Image size 2352x1568, fundus photo — 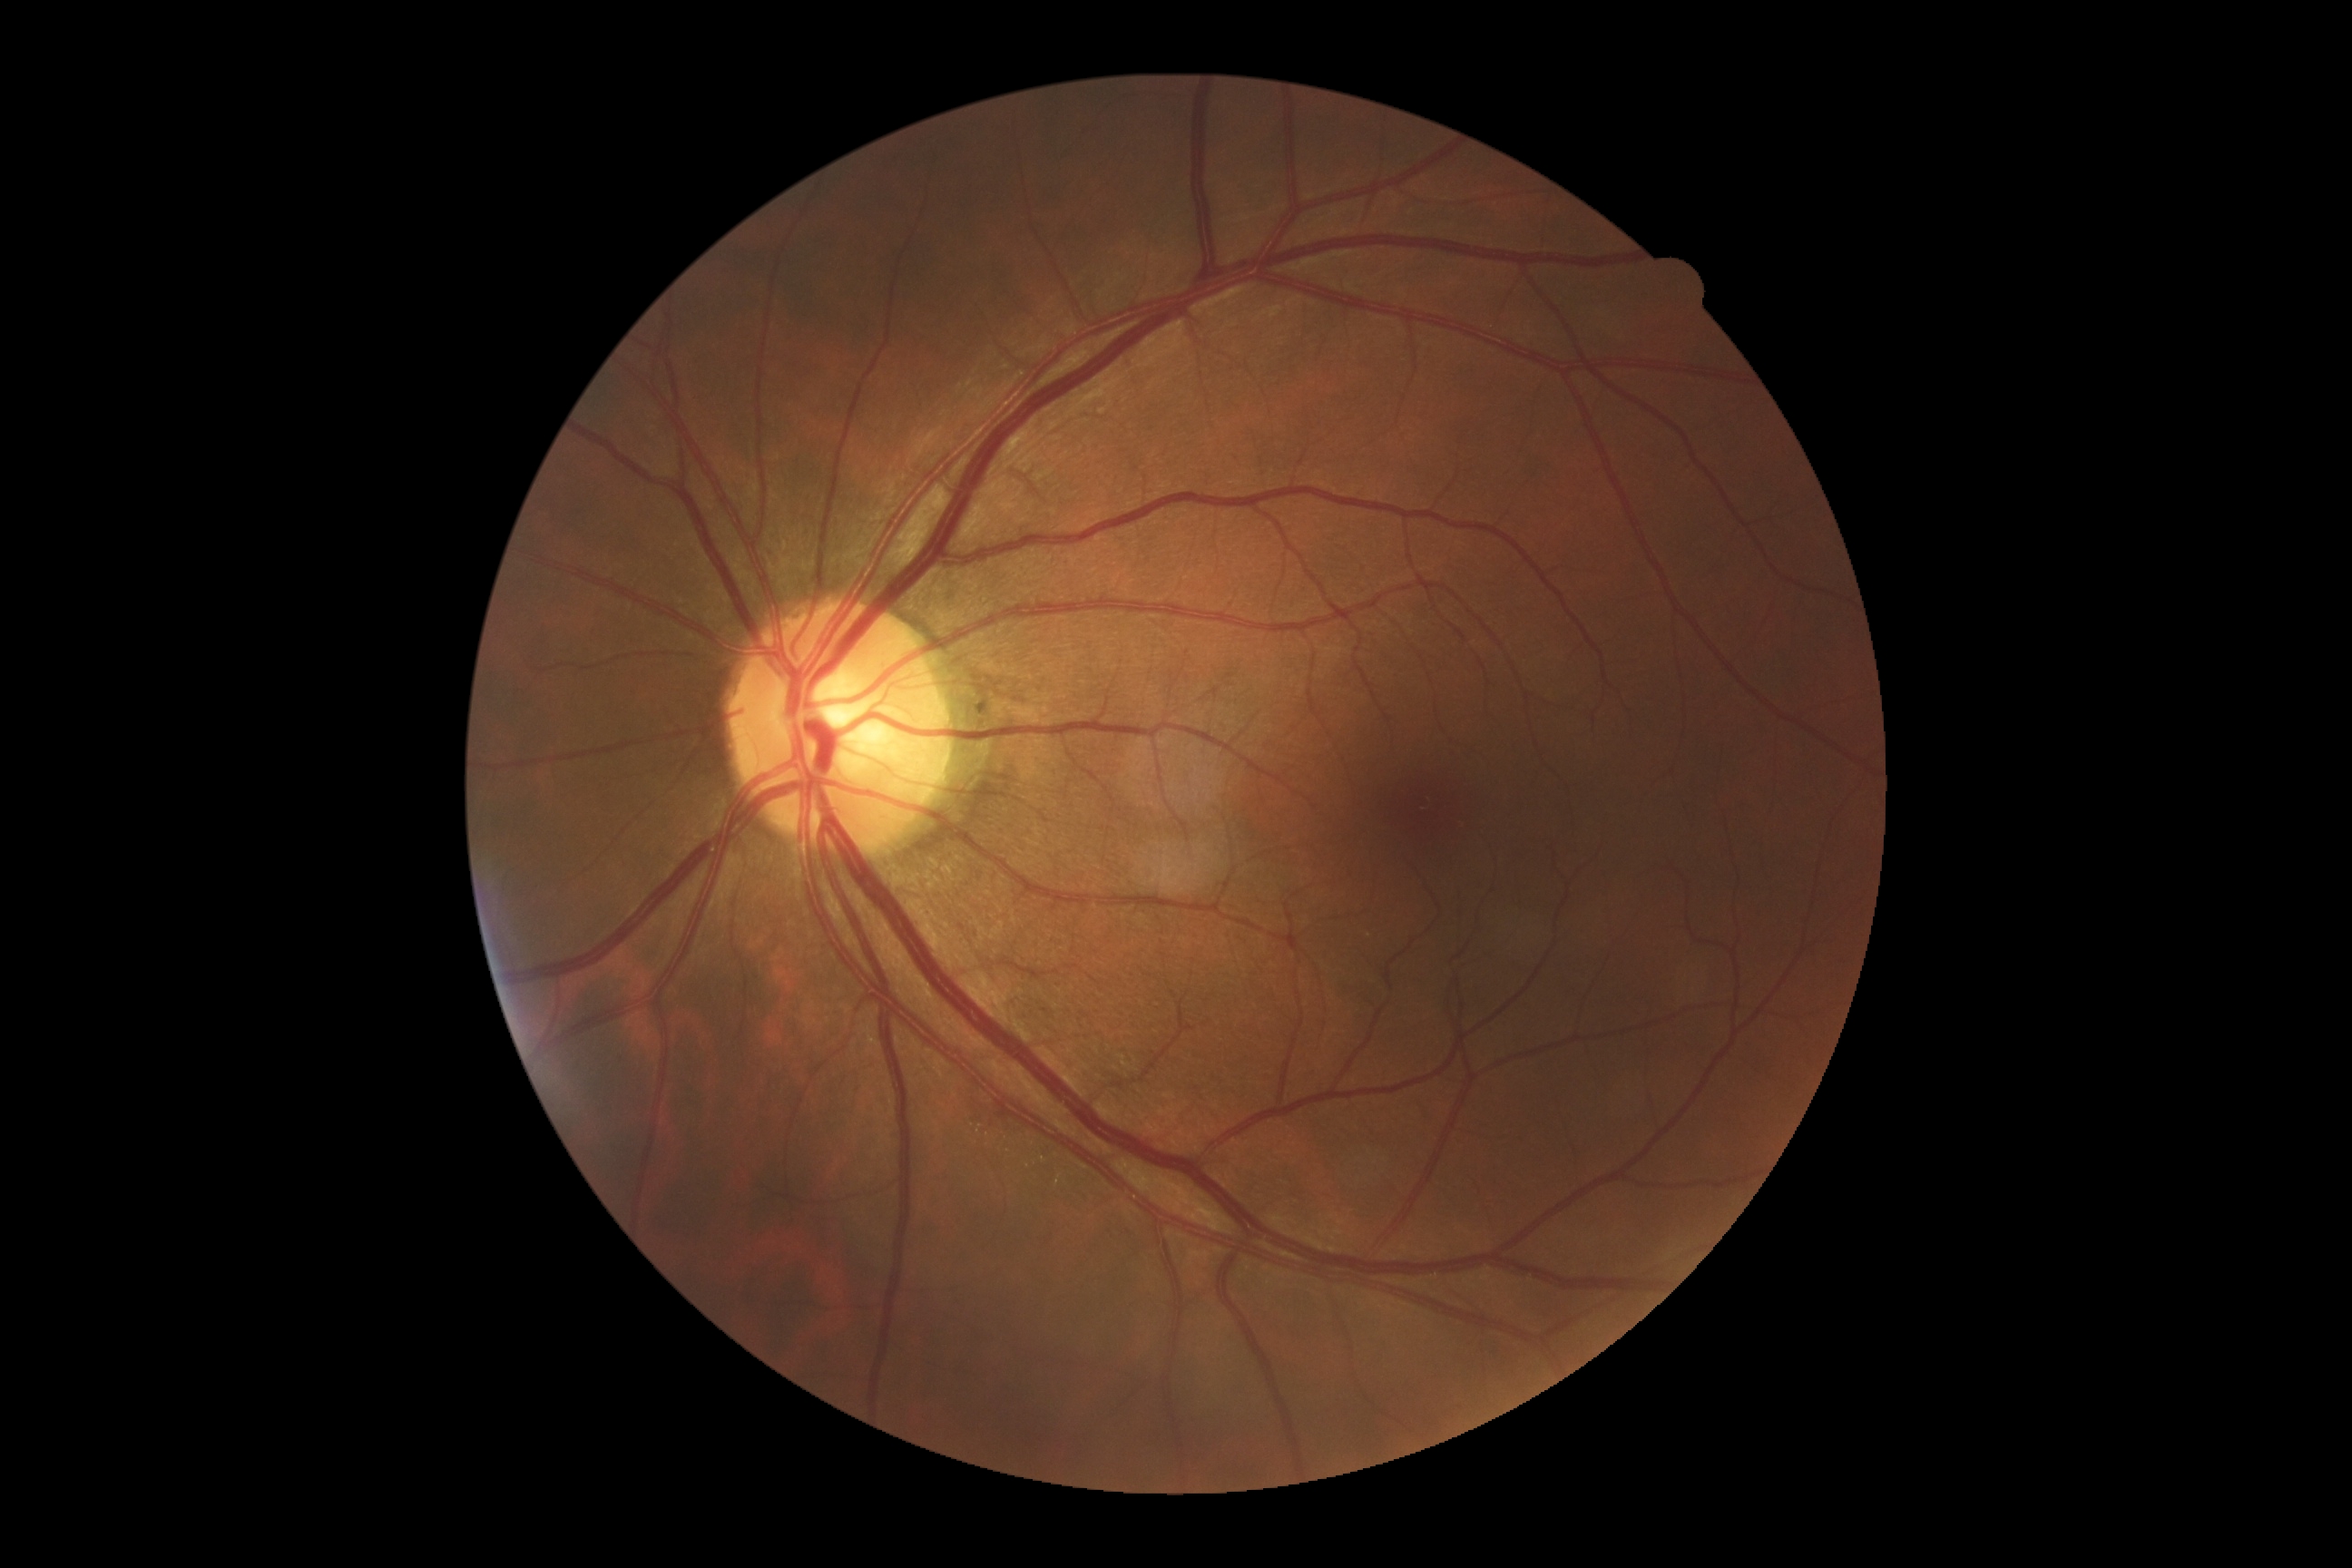 DR is grade 0.